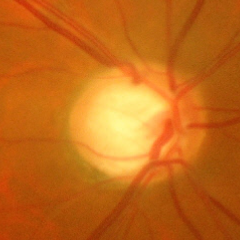

Glaucoma is present. Glaucoma status = severe glaucomatous damage.